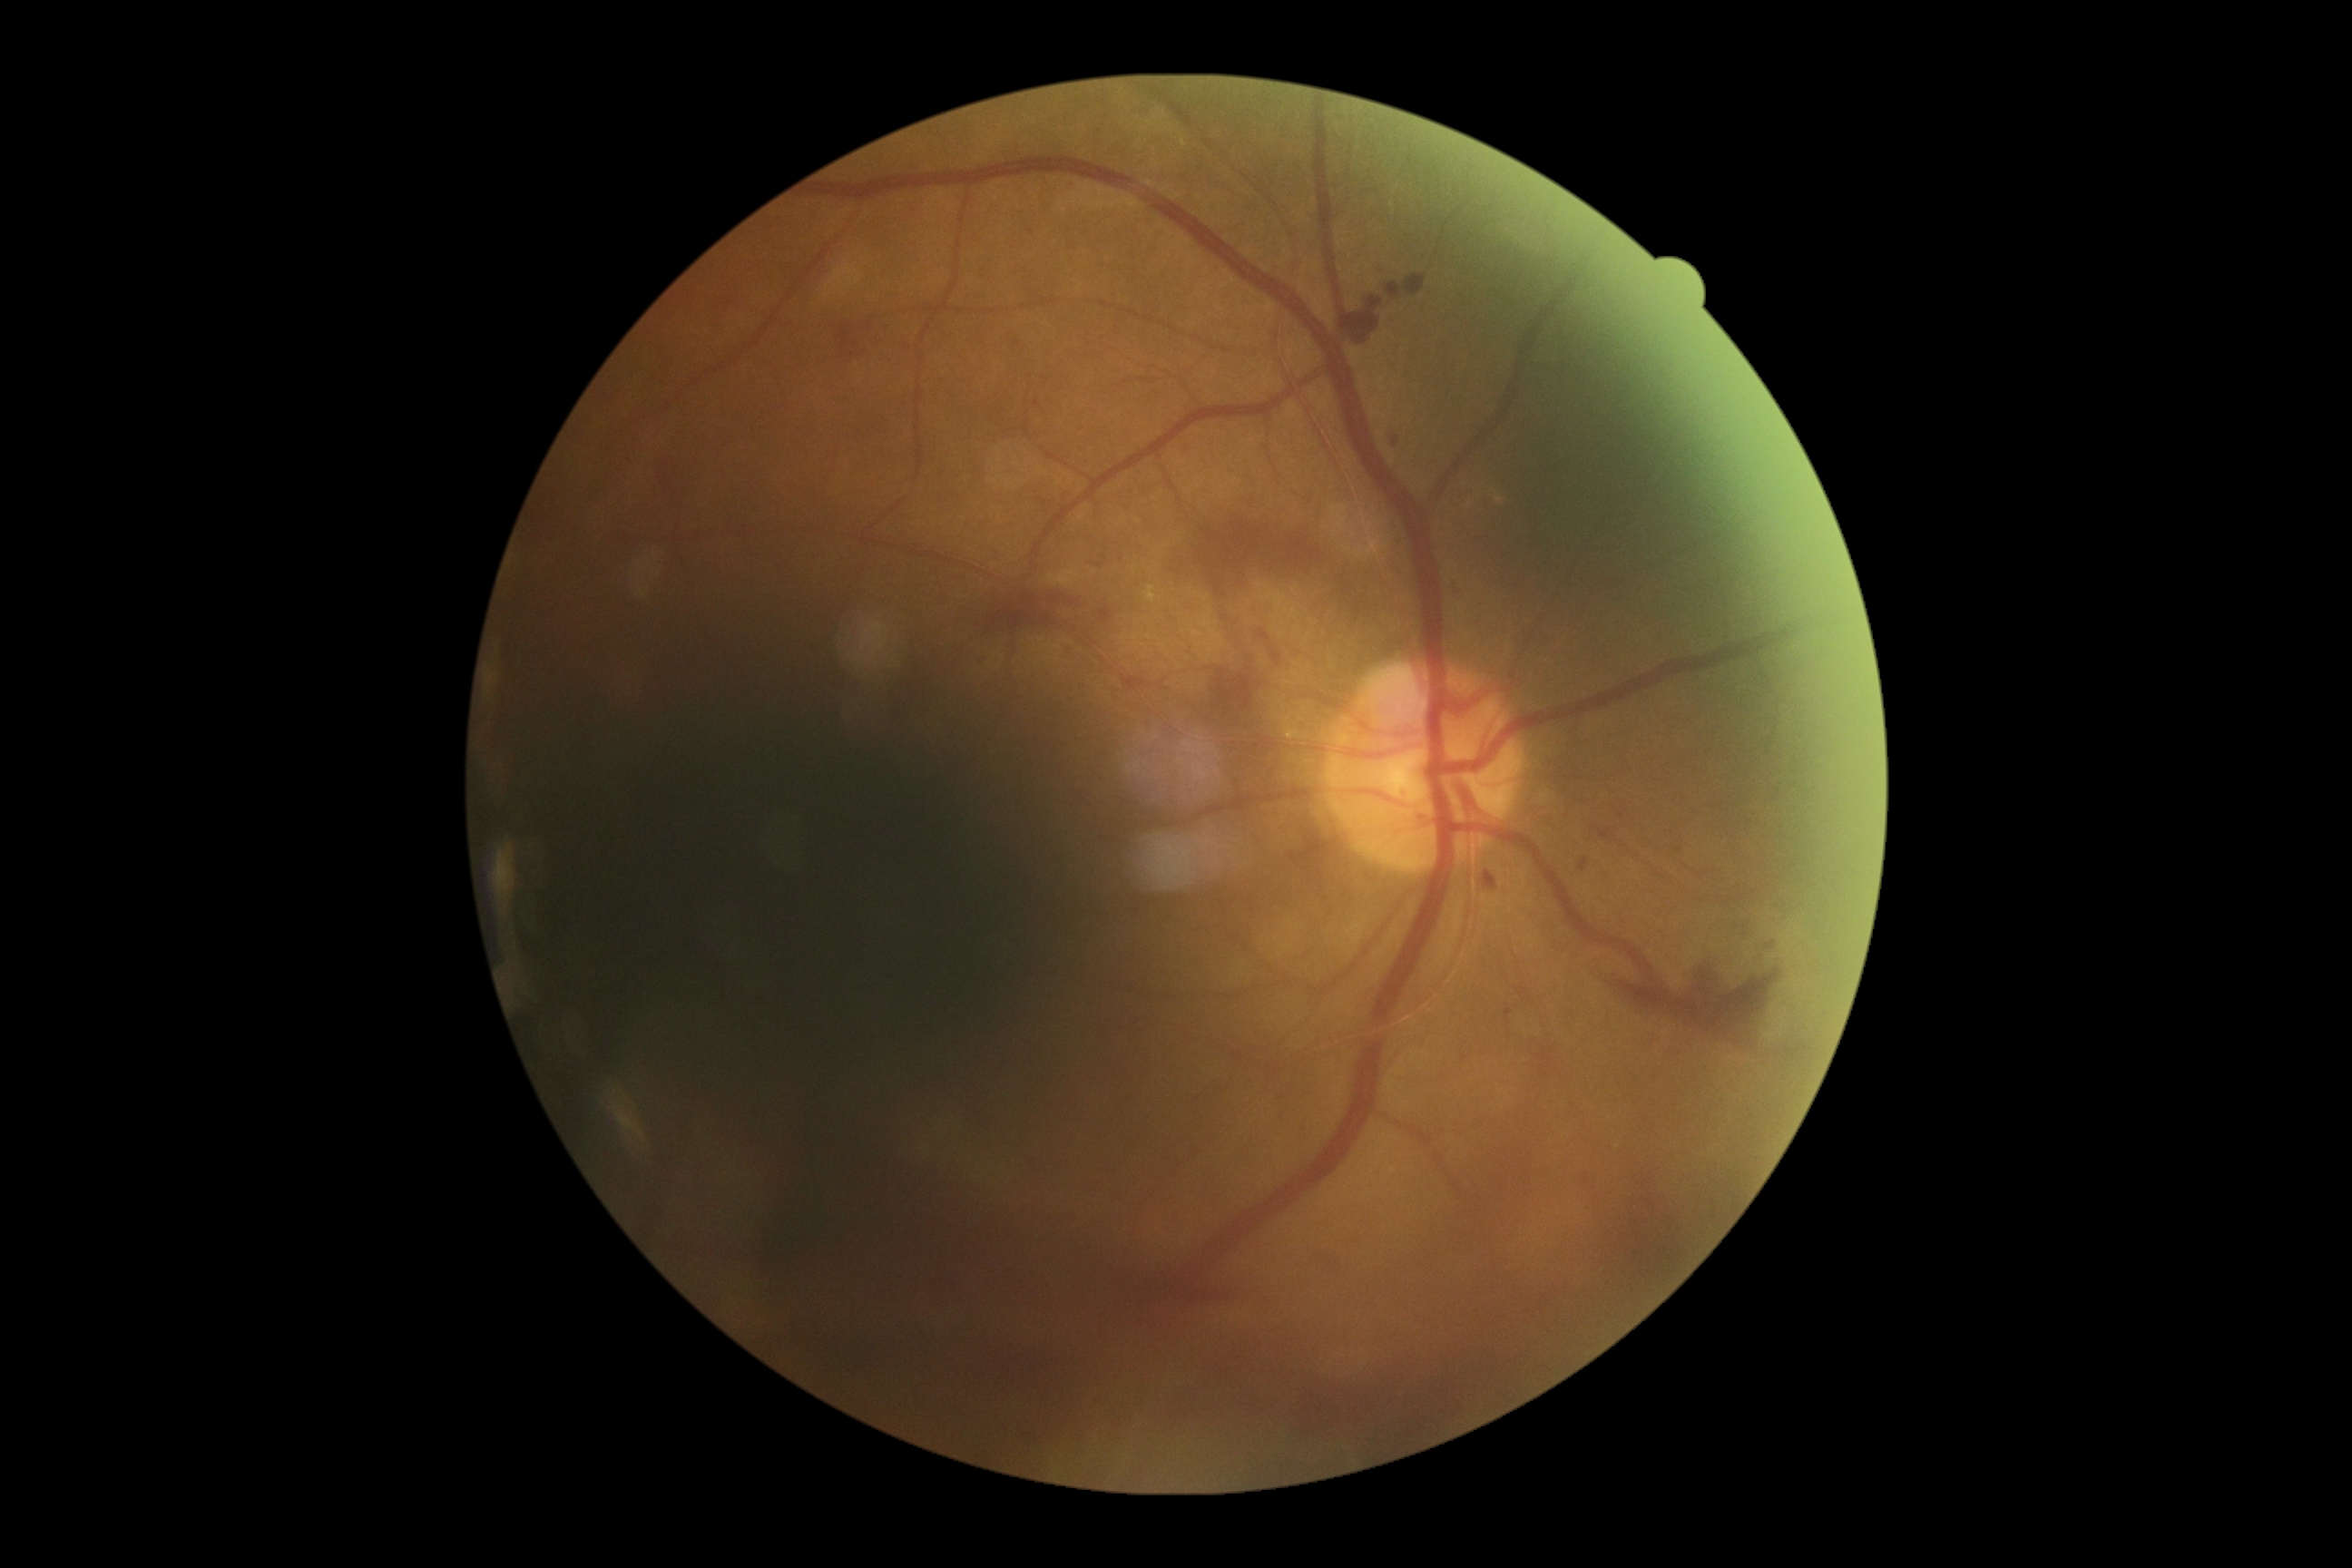 Findings:
• DR severity — 4